Color fundus image · FOV: 45 degrees:
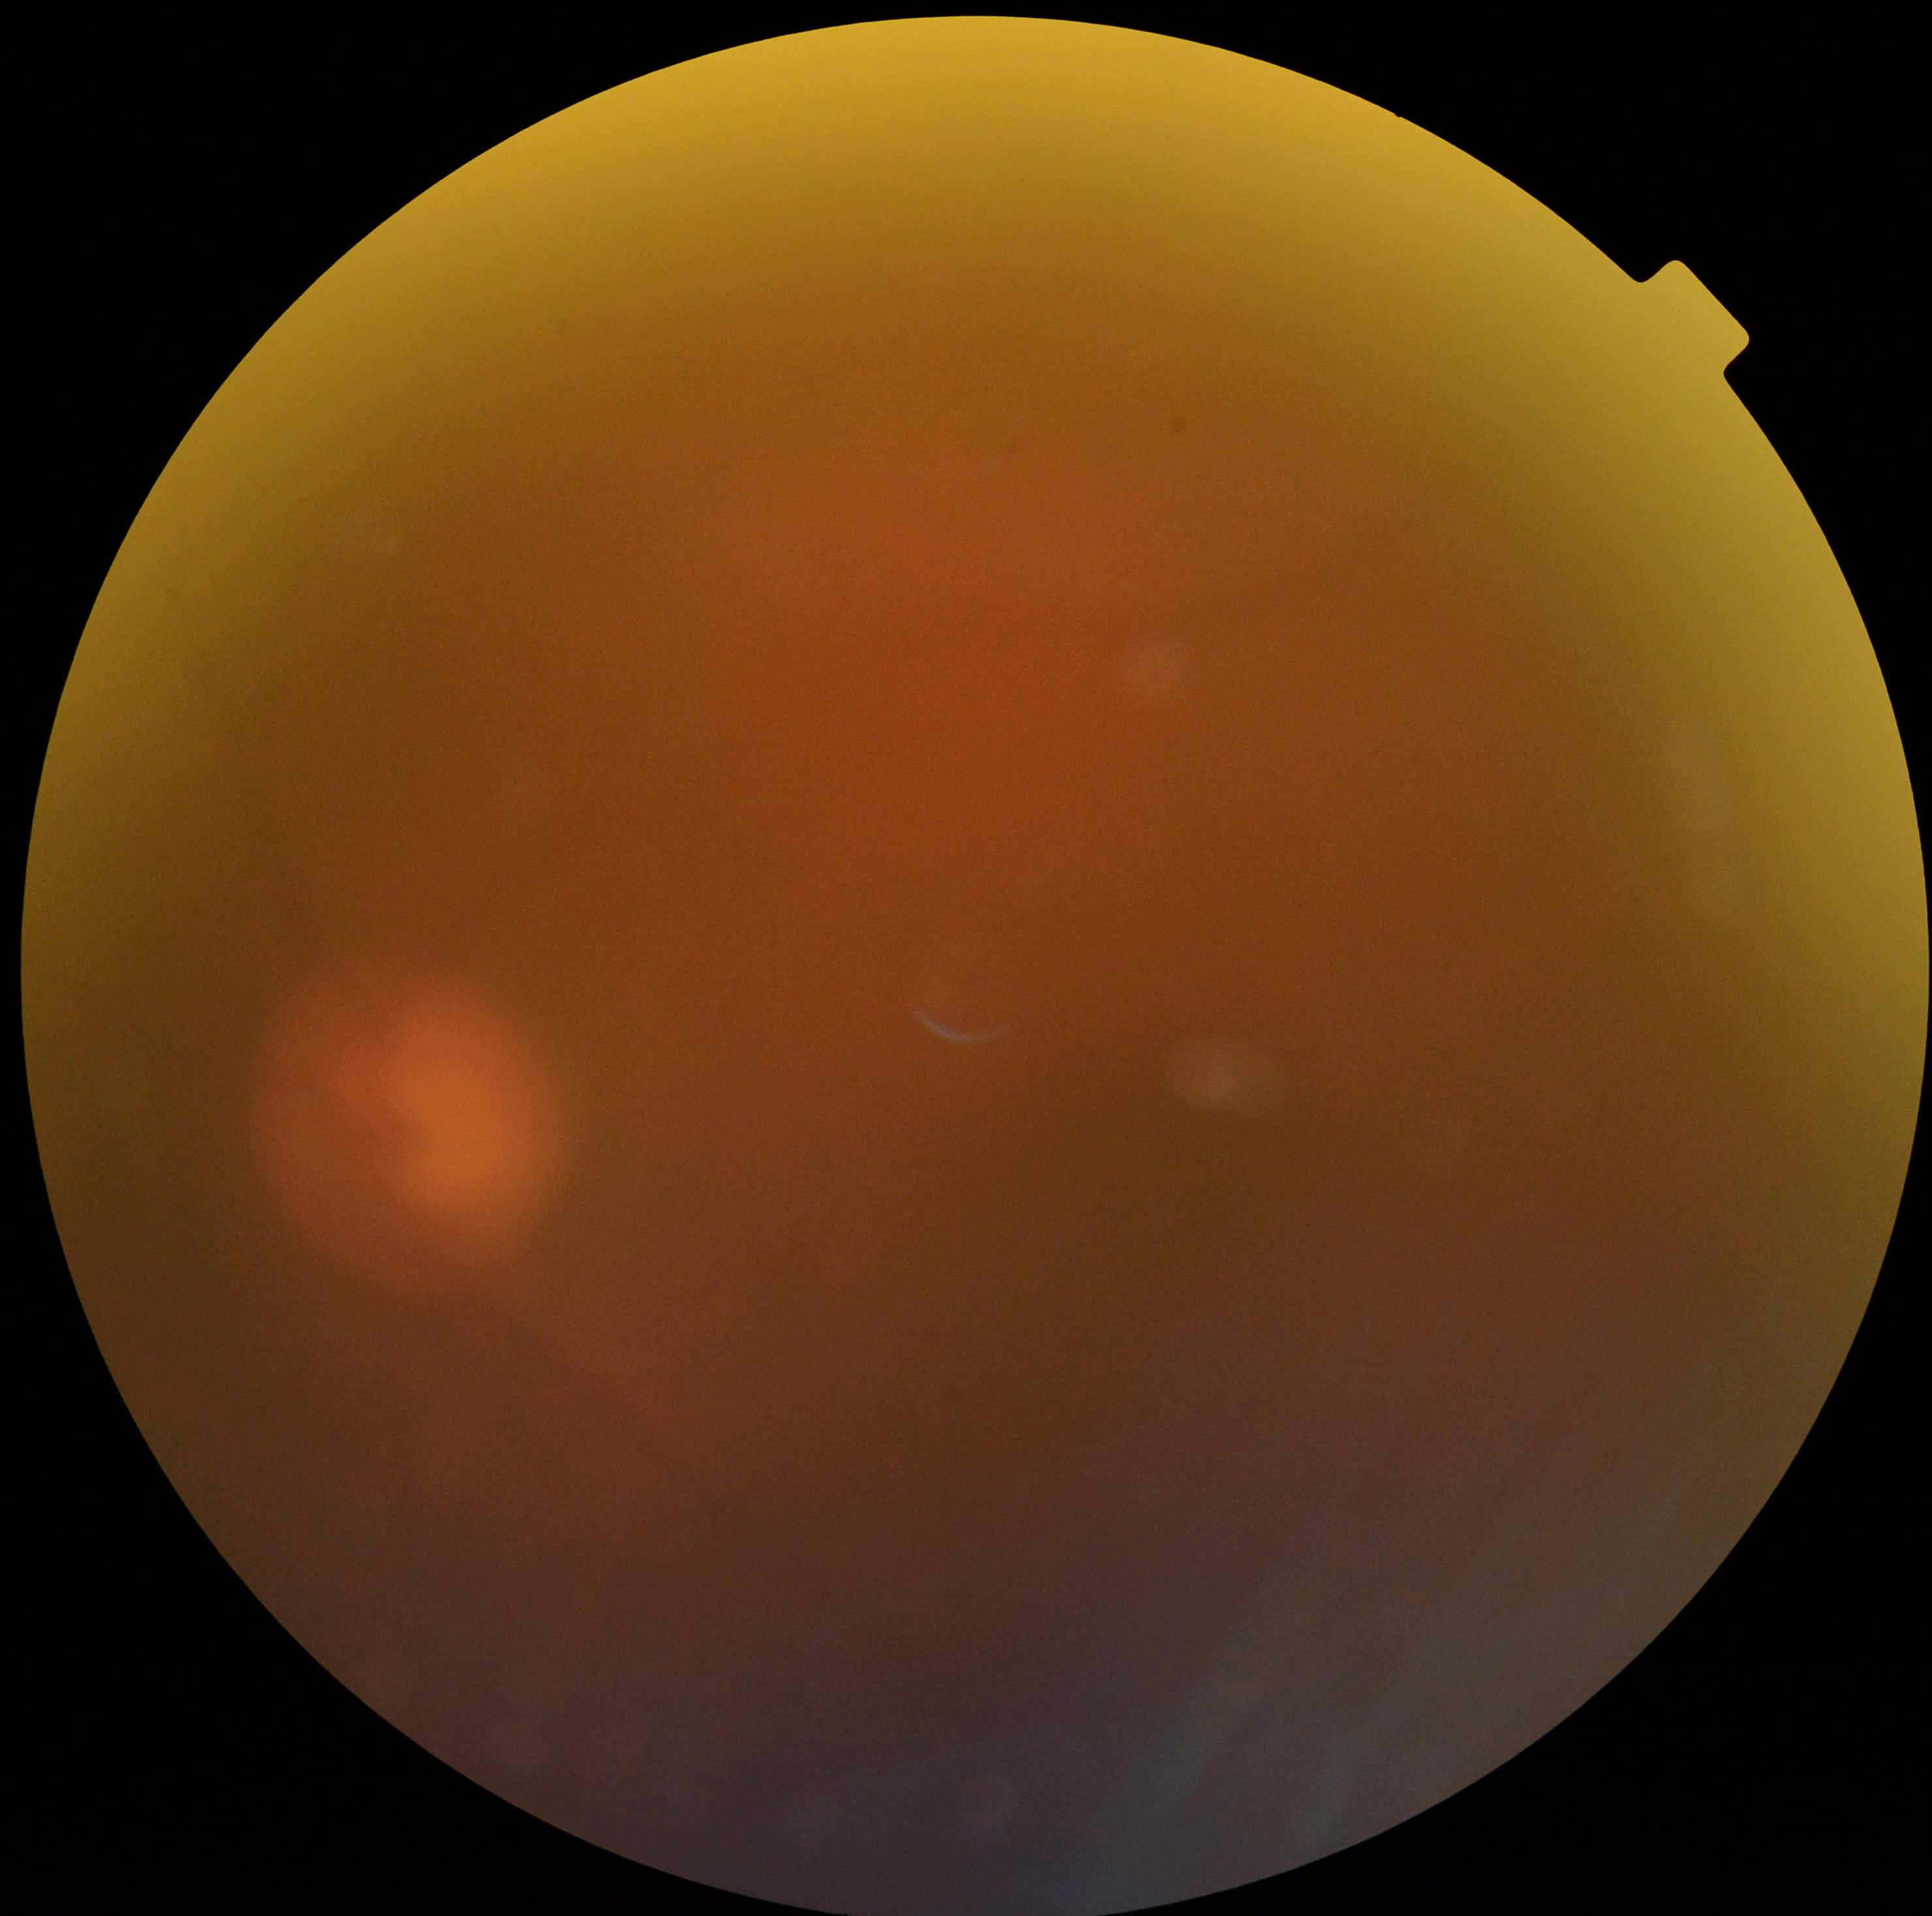
DR severity: ungradable.